Graded on the modified Davis scale — 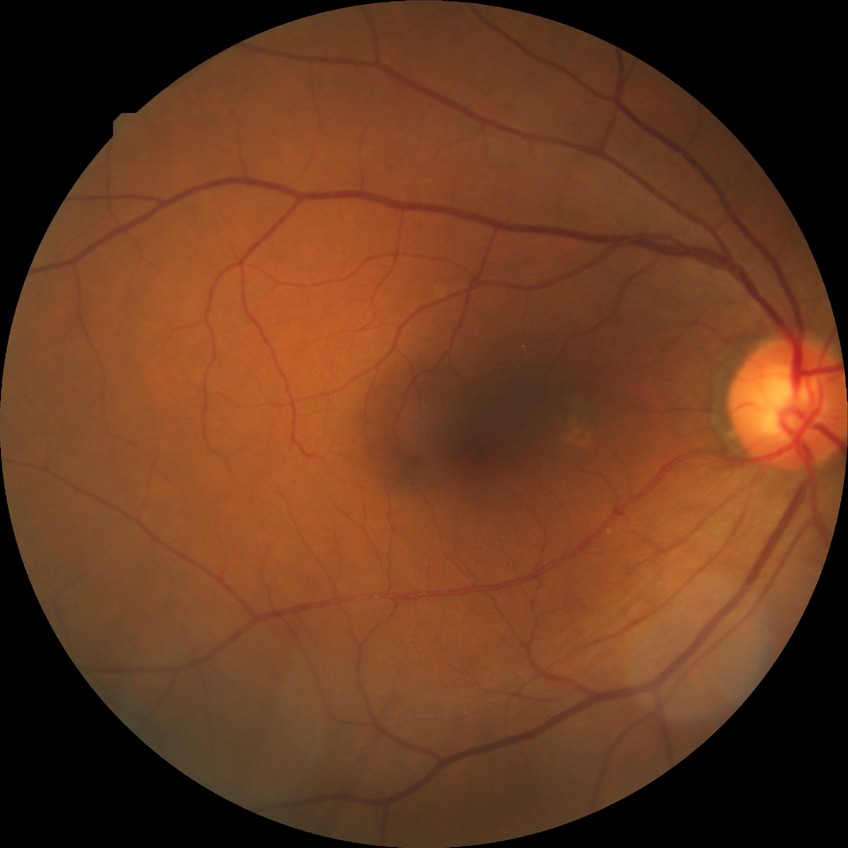 diabetic retinopathy (DR): NDR (no diabetic retinopathy).